50° field of view. Camera: Topcon TRC-NW8: 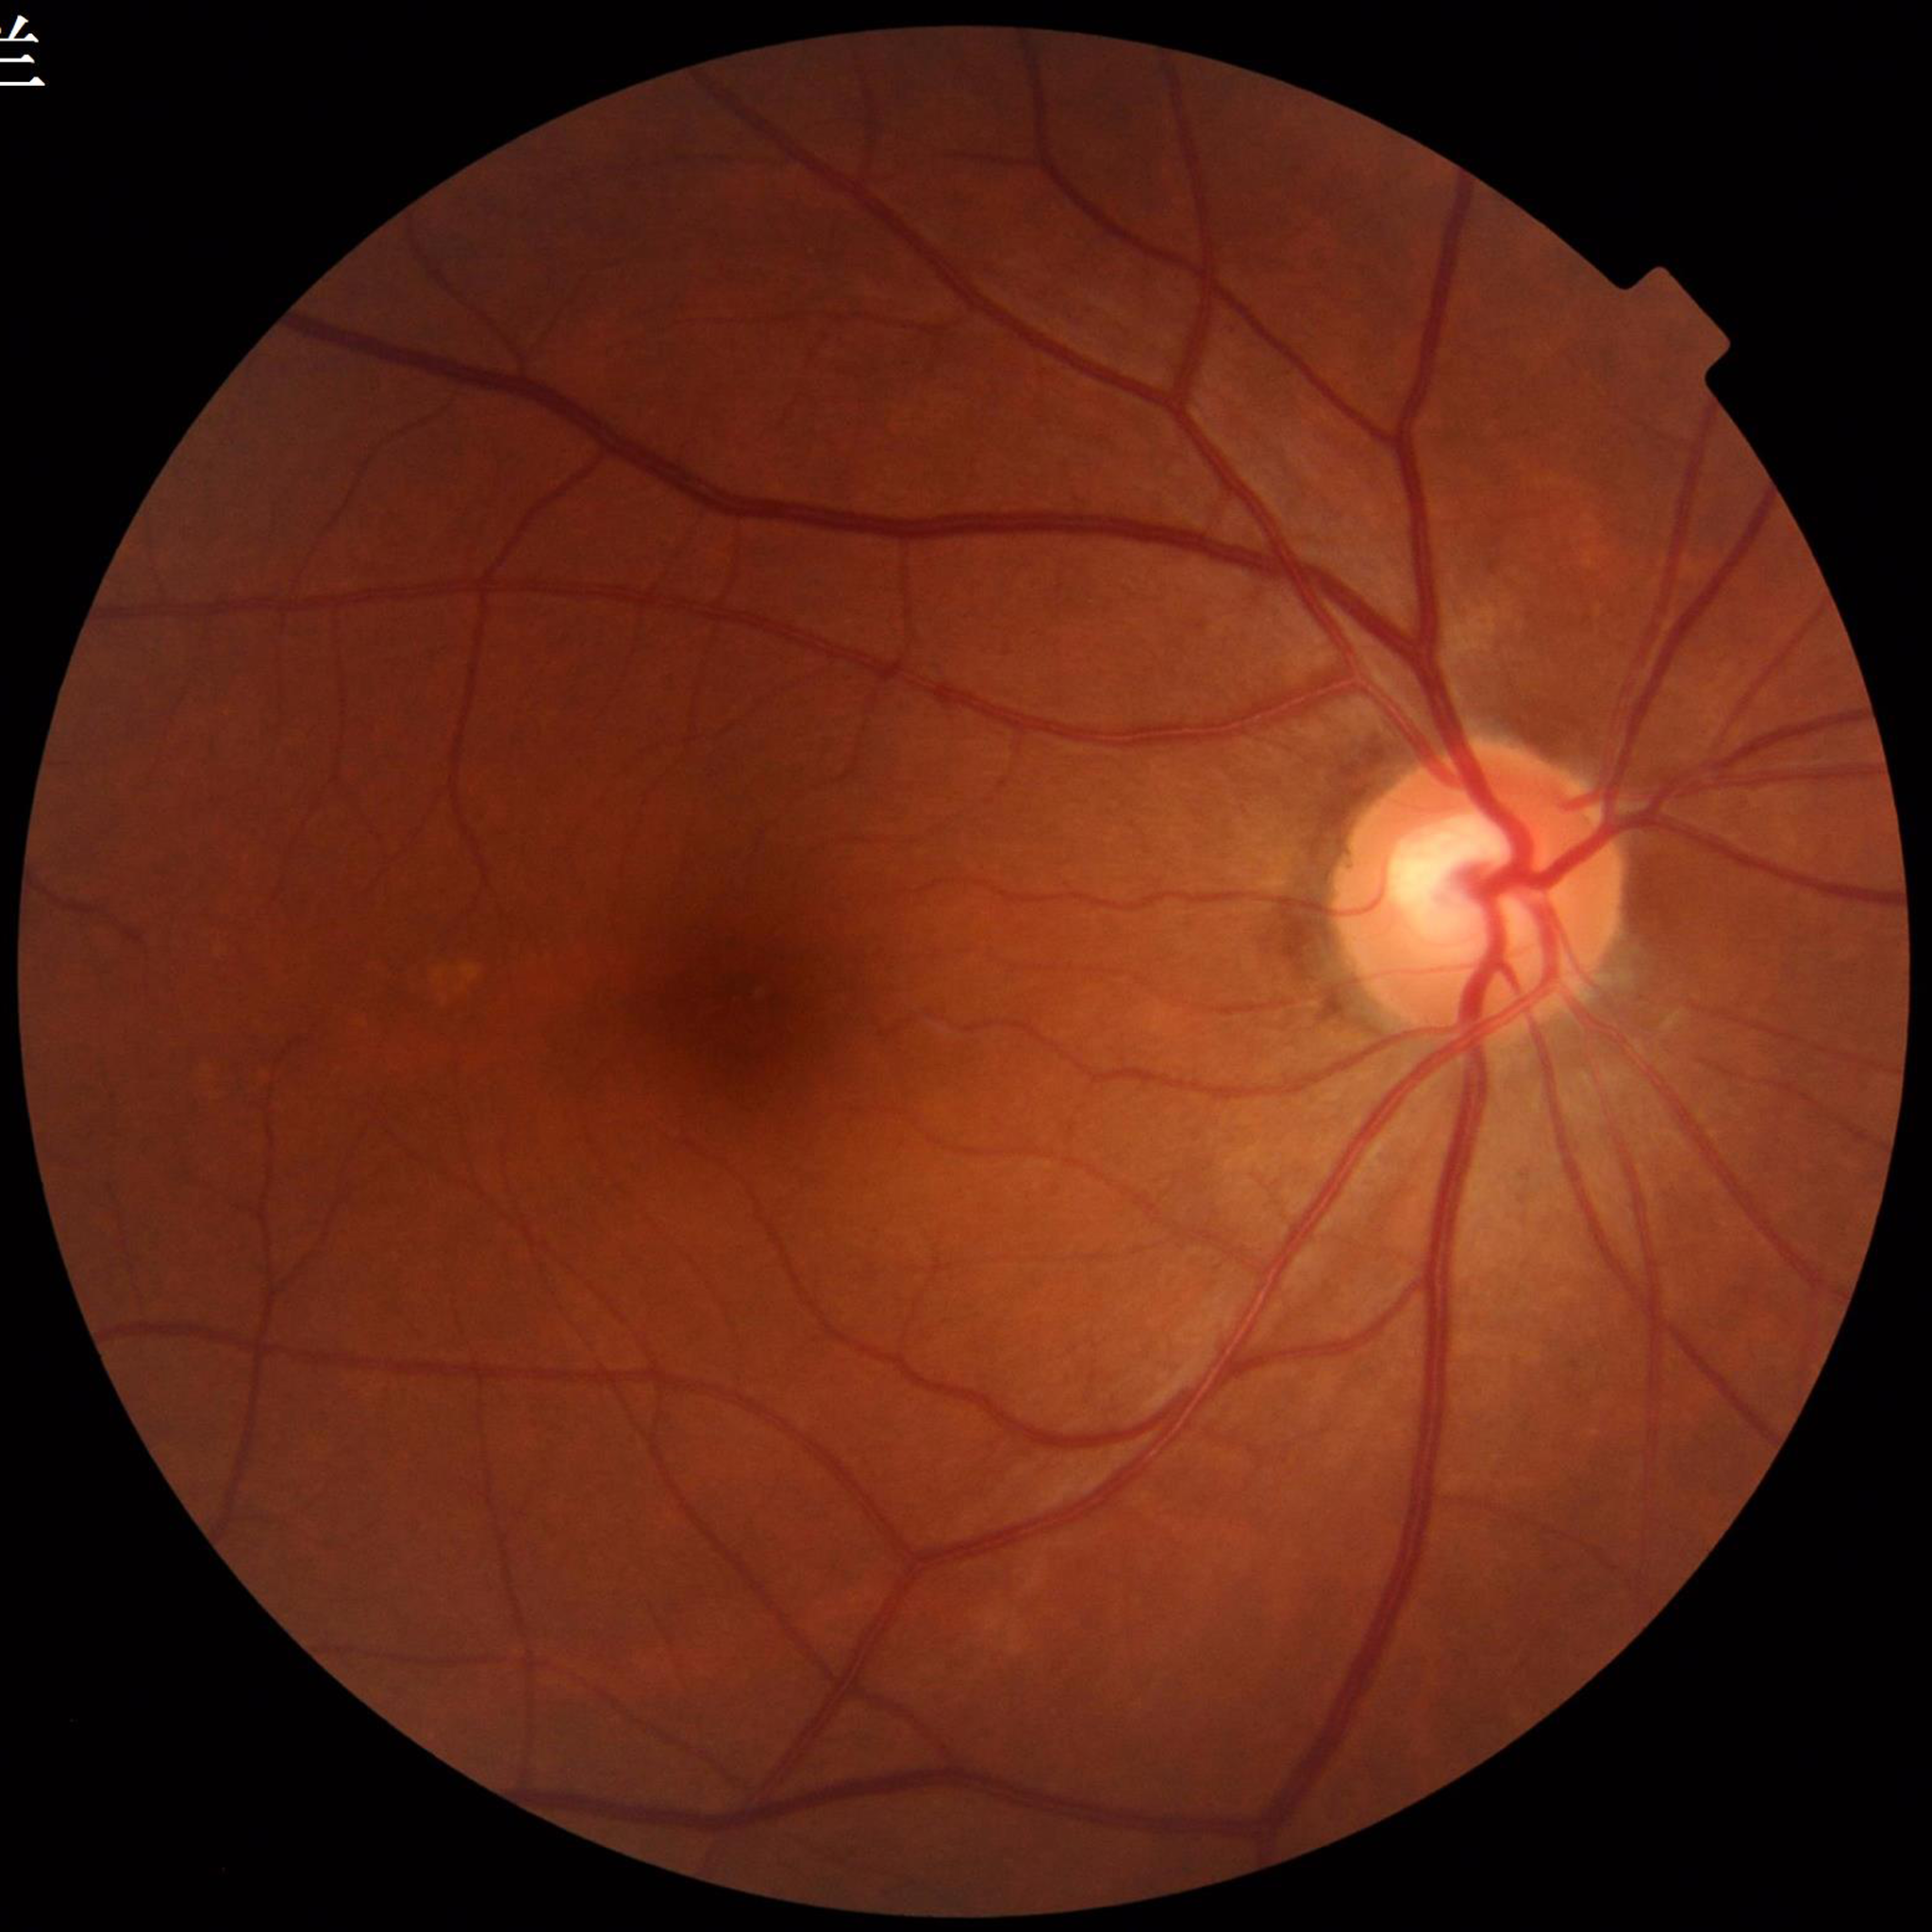 Disease class: DR.